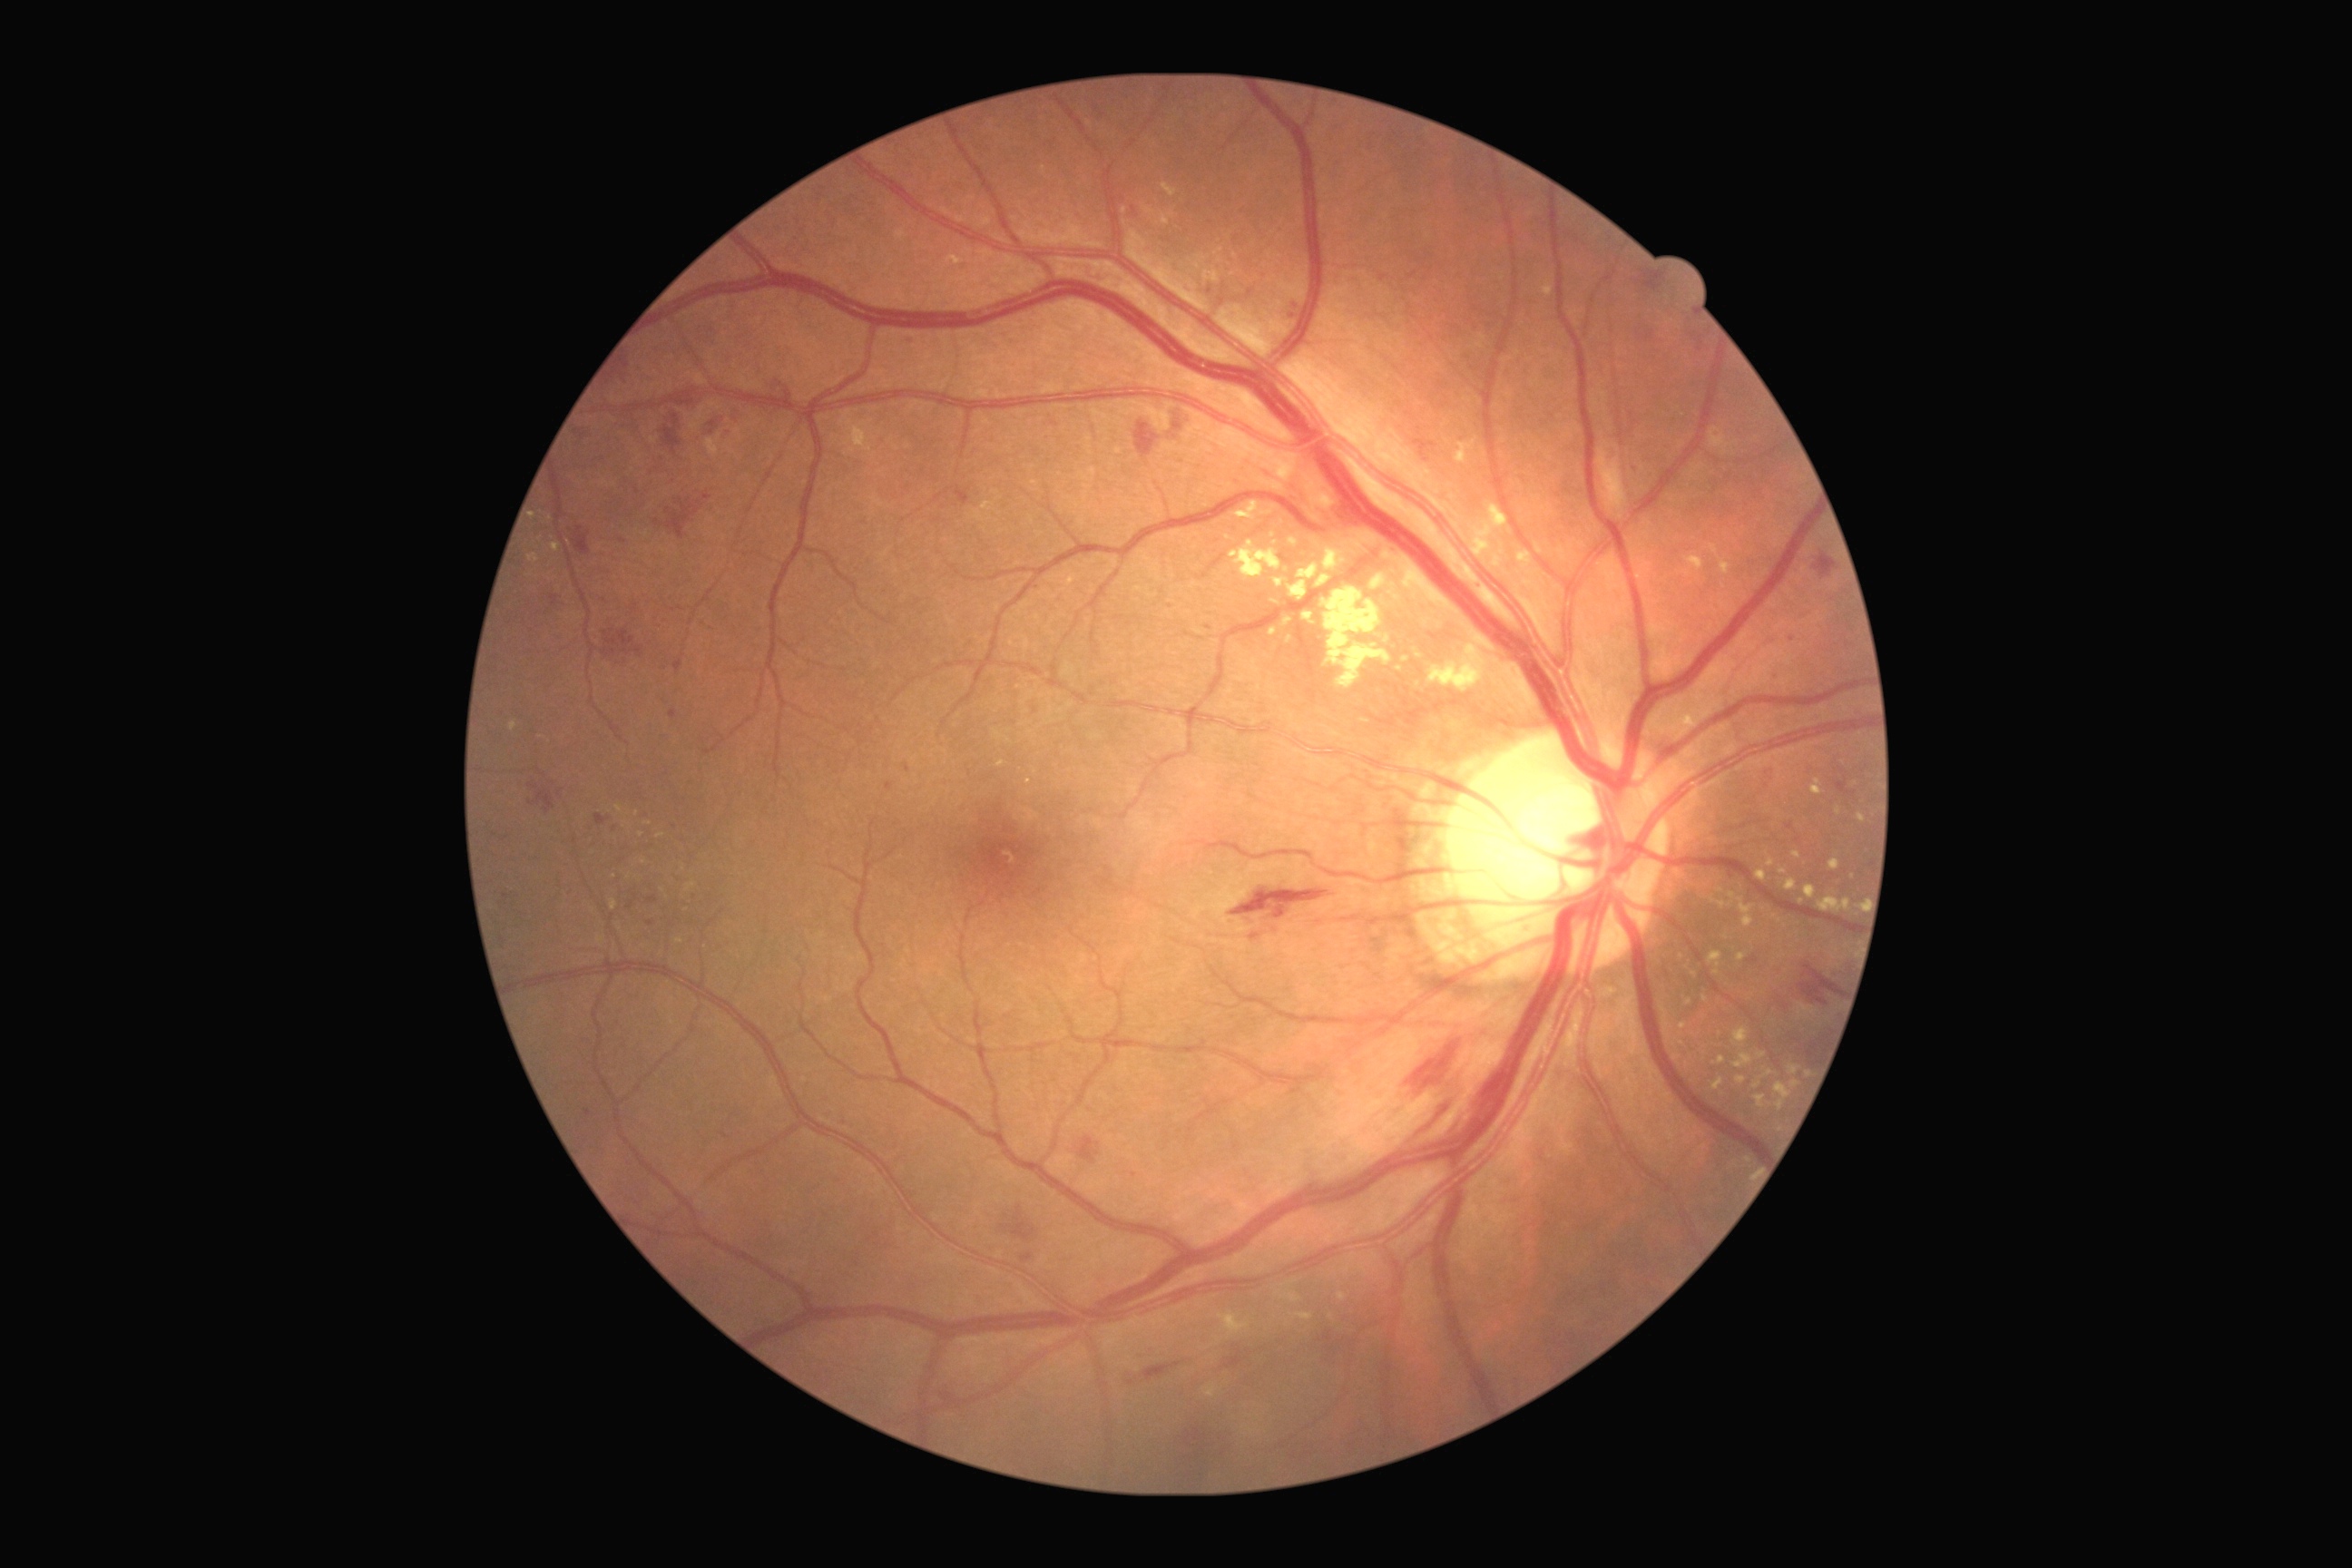

Diabetic retinopathy: grade 2 (moderate NPDR) — more than just microaneurysms but less than severe NPDR
Selected lesions:
hard exudates (partial): {"left": 1487, "top": 504, "right": 1514, "bottom": 531} | {"left": 1703, "top": 995, "right": 1709, "bottom": 1003} | {"left": 1289, "top": 582, "right": 1308, "bottom": 602} | {"left": 1836, "top": 807, "right": 1841, "bottom": 816} | {"left": 1694, "top": 968, "right": 1703, "bottom": 975} | {"left": 1788, "top": 1064, "right": 1801, "bottom": 1075} | {"left": 1324, "top": 549, "right": 1344, "bottom": 571} | {"left": 1754, "top": 1095, "right": 1767, "bottom": 1108} | {"left": 1714, "top": 903, "right": 1727, "bottom": 908} | {"left": 1162, "top": 213, "right": 1170, "bottom": 226} | {"left": 1542, "top": 280, "right": 1553, "bottom": 297} | {"left": 1475, "top": 536, "right": 1487, "bottom": 554} | {"left": 1738, "top": 954, "right": 1747, "bottom": 963} | {"left": 1302, "top": 612, "right": 1313, "bottom": 622}
Hard exudates (small, approximate centers) near [x=687, y=910] | [x=1774, y=916] | [x=1683, y=1026] | [x=1802, y=902]